Color fundus photograph · 45° FOV · image size 848x848:
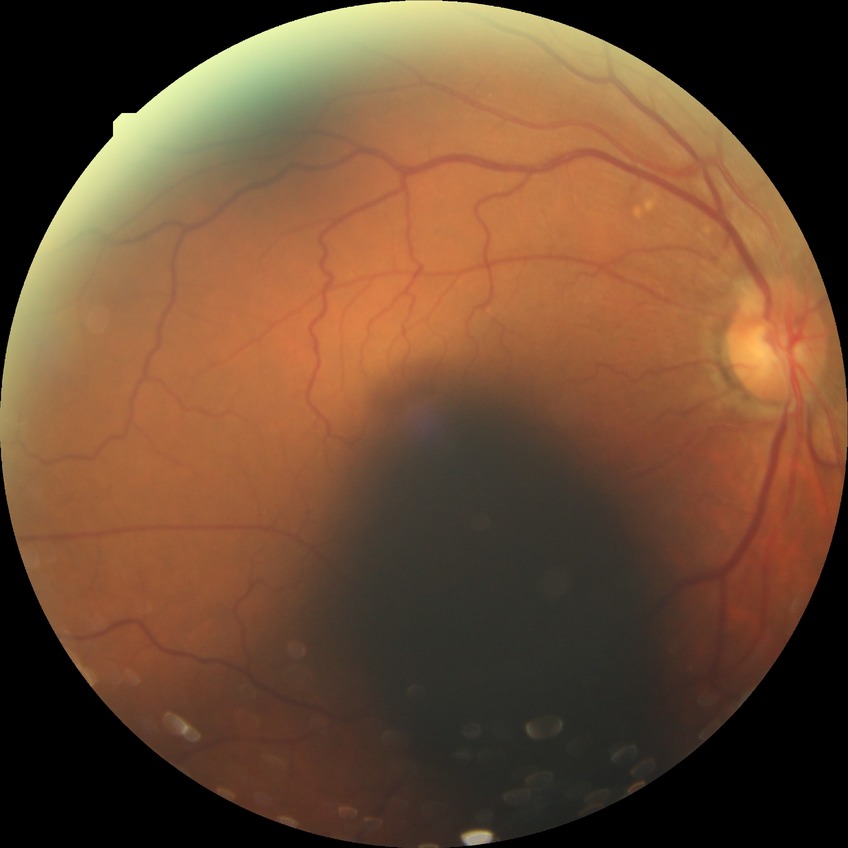

diabetic retinopathy (DR) = simple diabetic retinopathy (SDR).